Wide-field fundus photograph of an infant
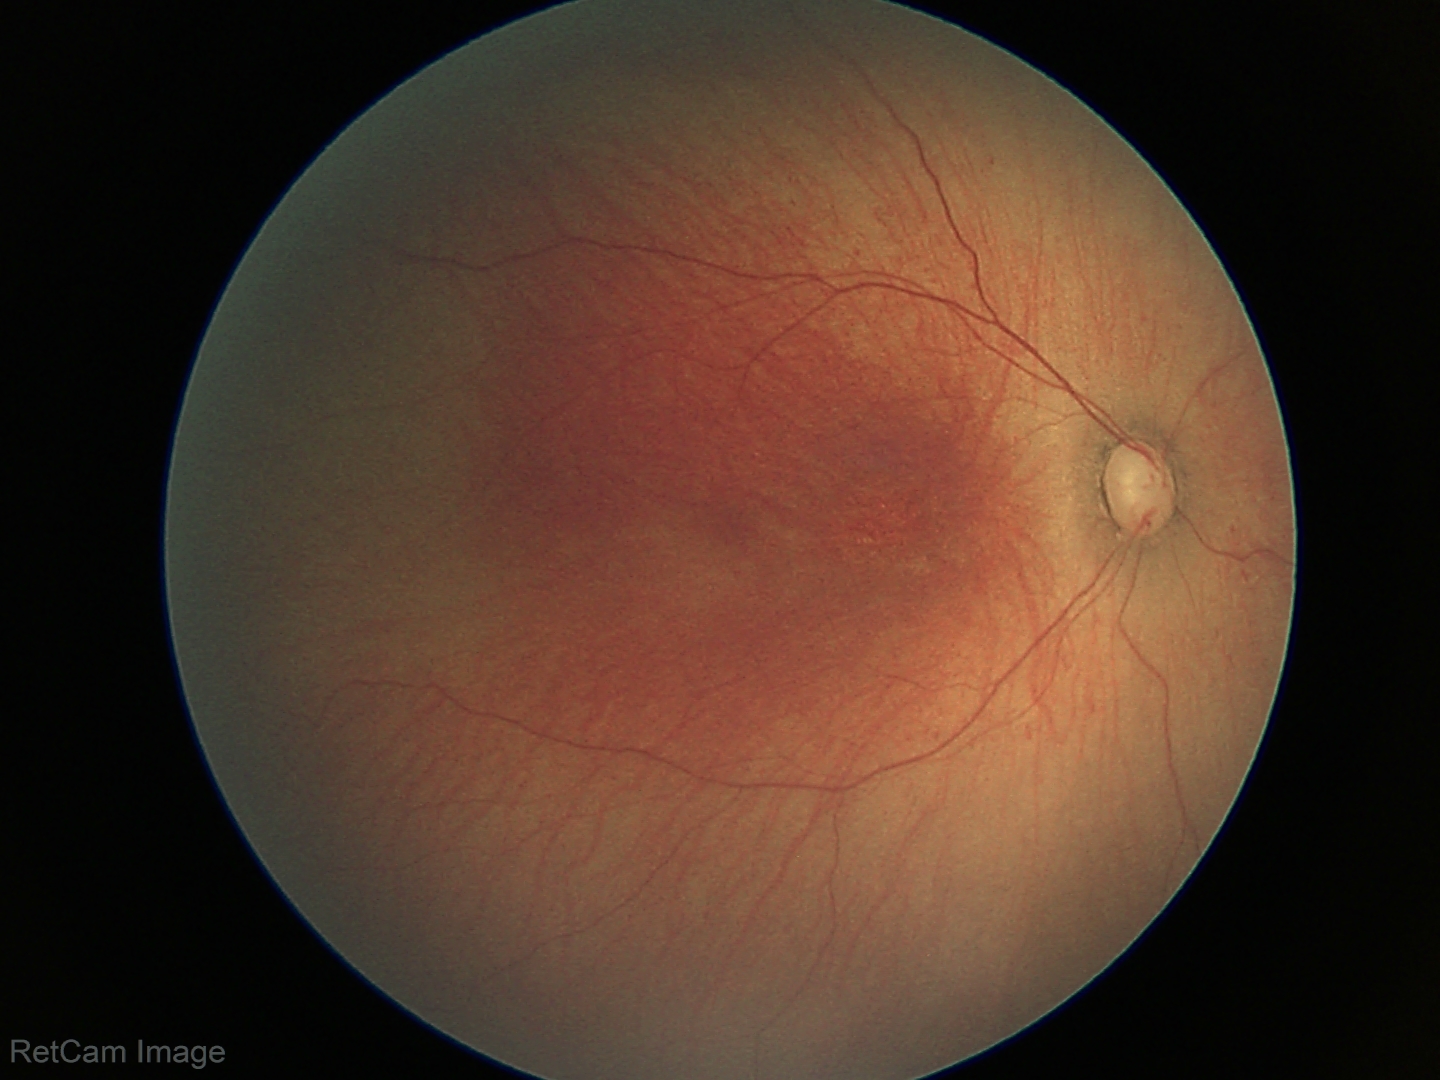

Without plus disease.
Examination diagnosed as retinopathy of prematurity stage 1 — demarcation line between vascular and avascular retina.